Modified Davis grading · no pharmacologic dilation · acquired with a NIDEK AFC-230
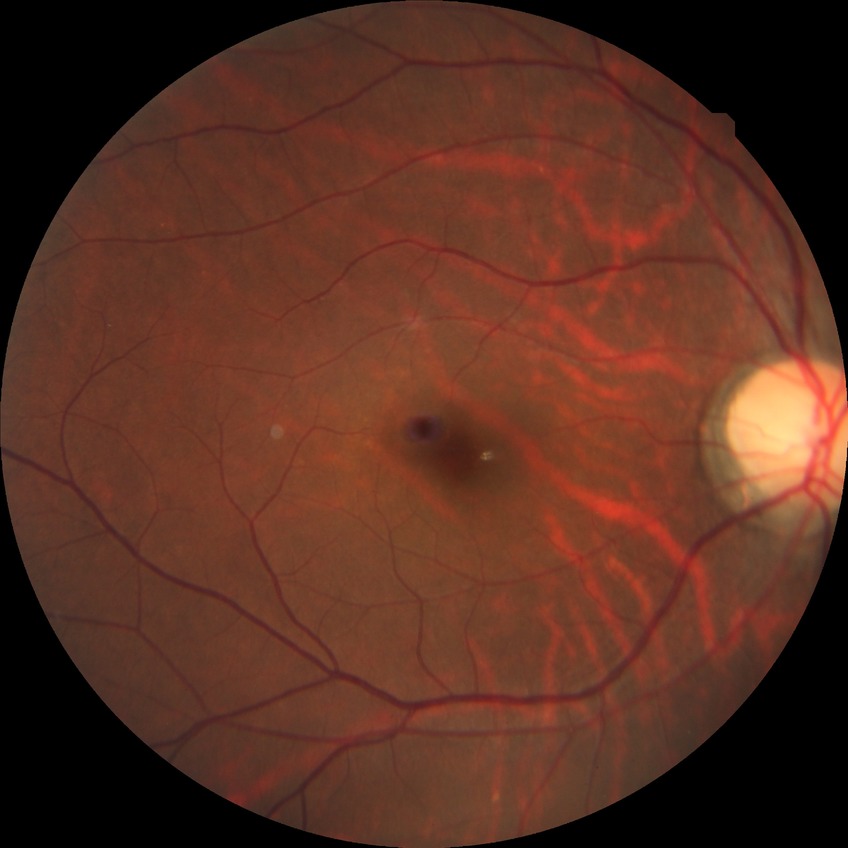 Davis grading: no diabetic retinopathy.